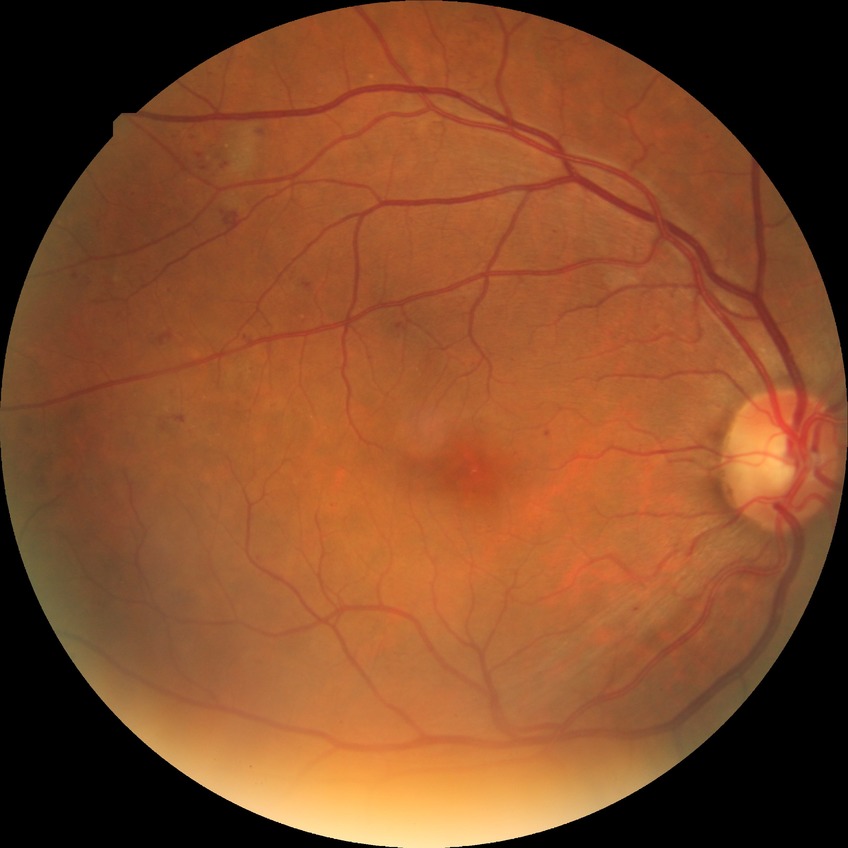 Assessment:
• diabetic retinopathy (DR) — pre-proliferative diabetic retinopathy (PPDR)
• DR class — non-proliferative diabetic retinopathy